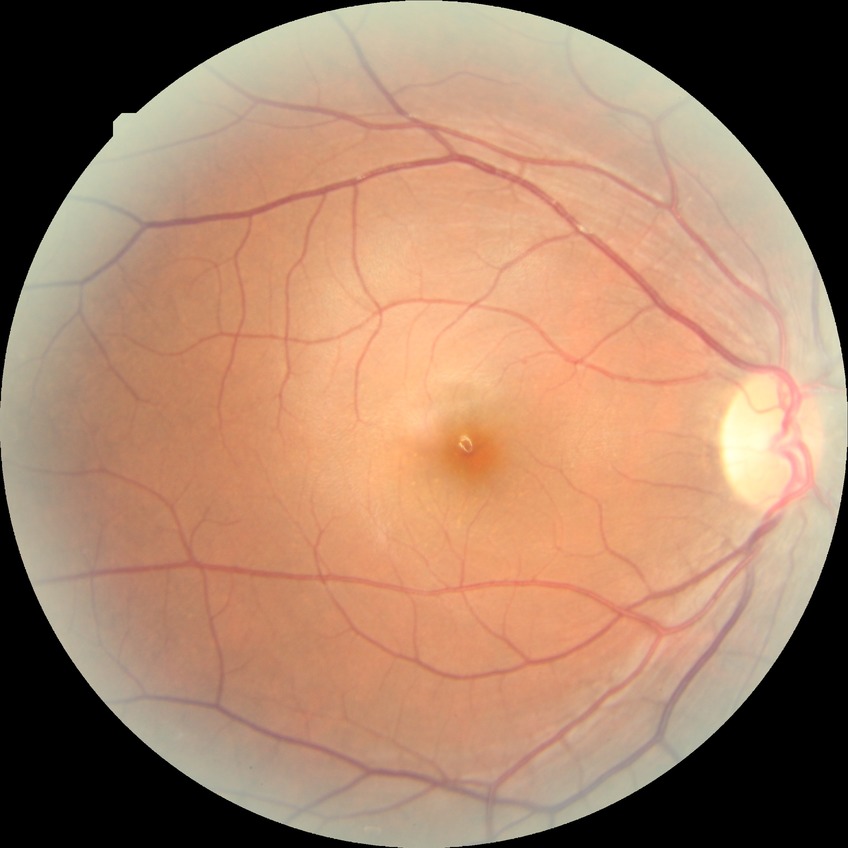 Diabetic retinopathy (DR) is NDR (no diabetic retinopathy).